NIDEK AFC-230 fundus camera:
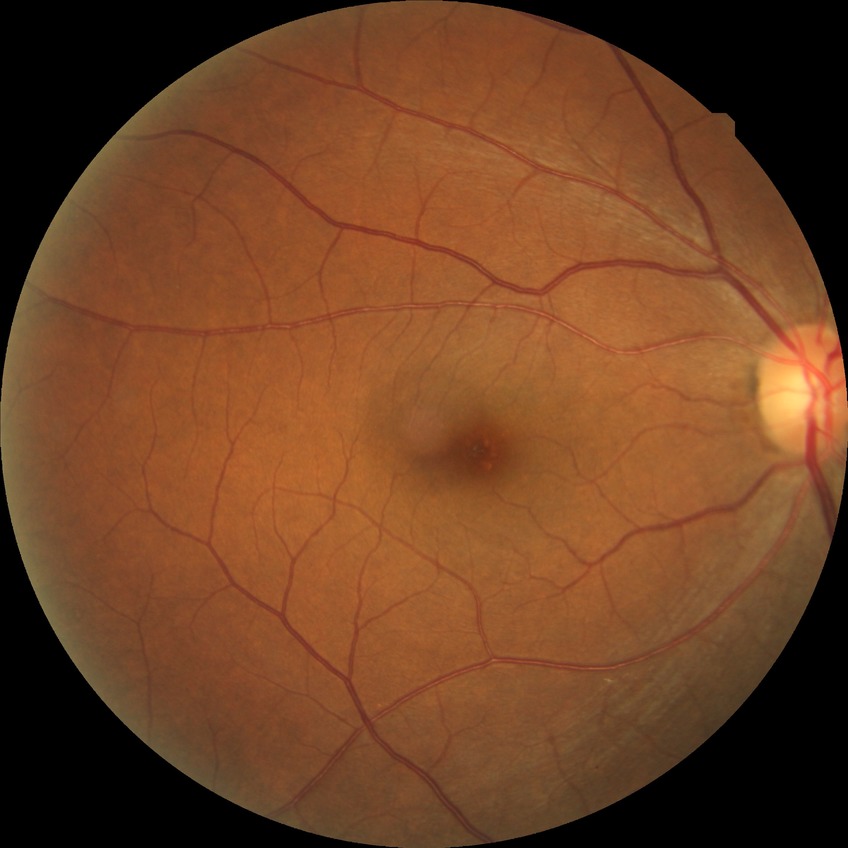

Diabetic retinopathy (DR) is NDR (no diabetic retinopathy).